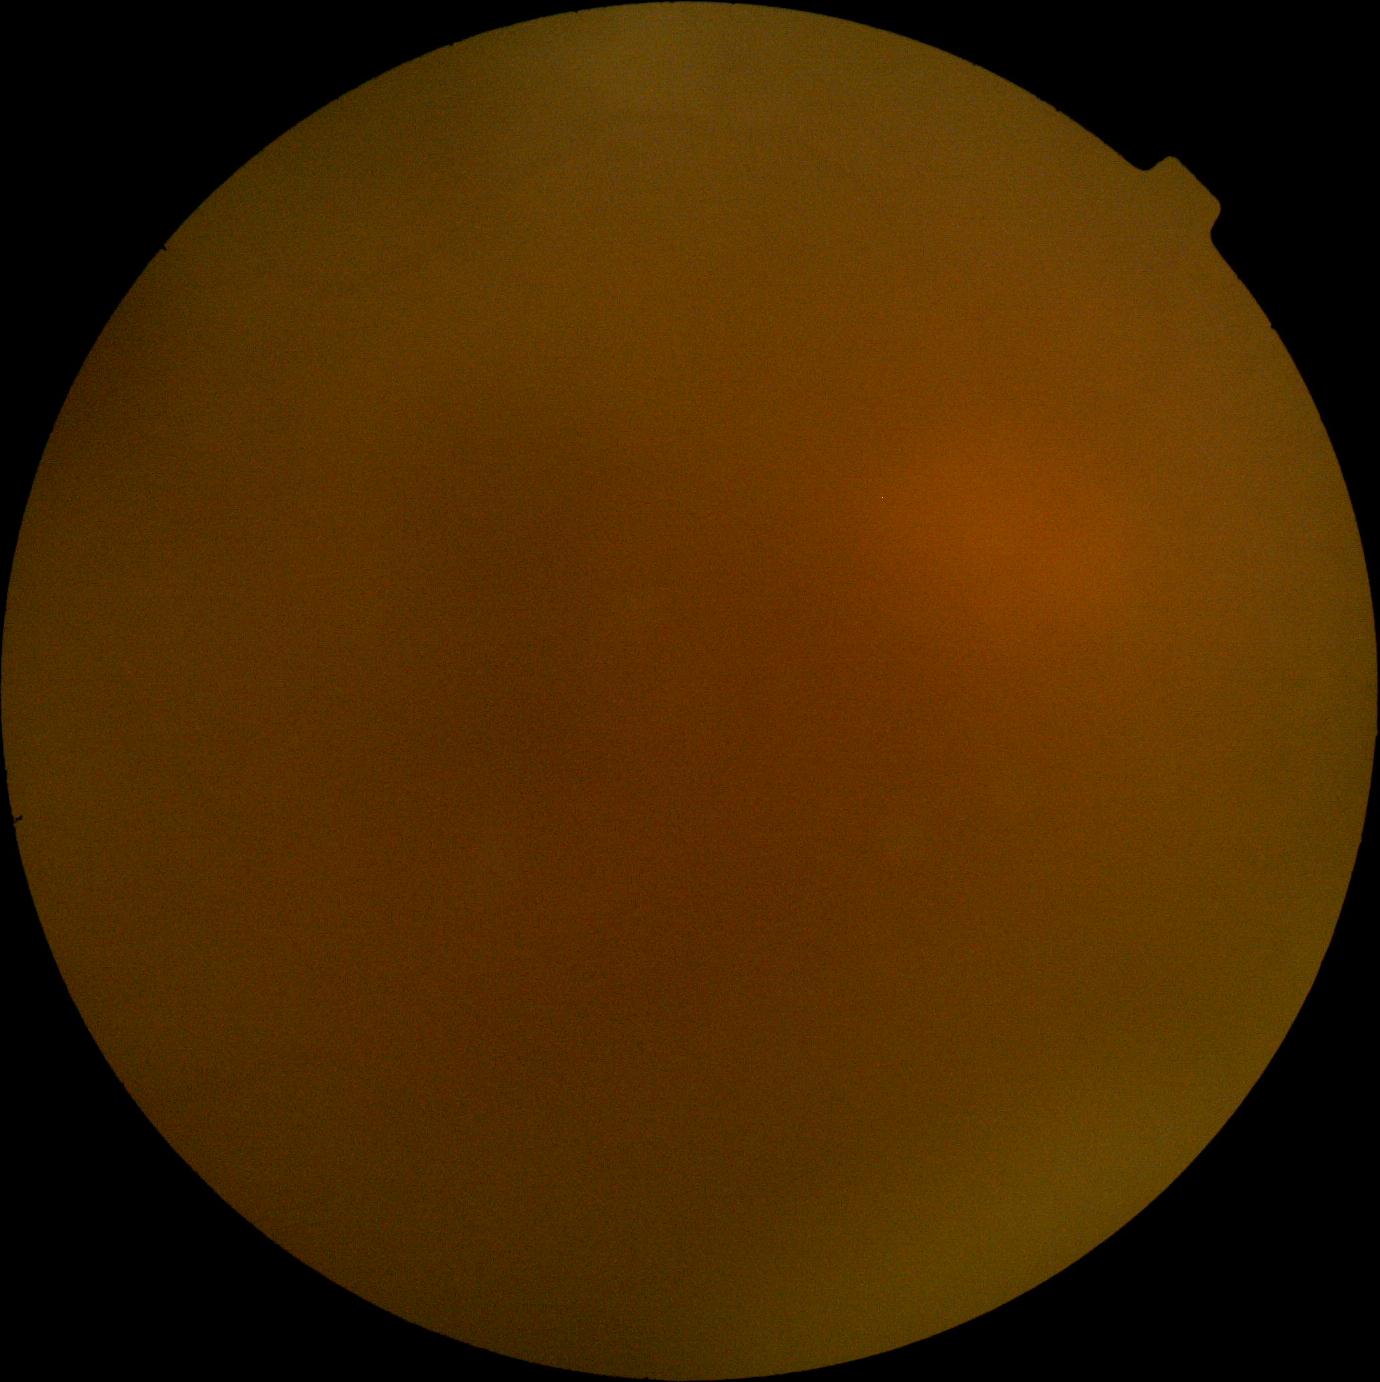
Diabetic retinopathy (DR): ungradable due to poor image quality.